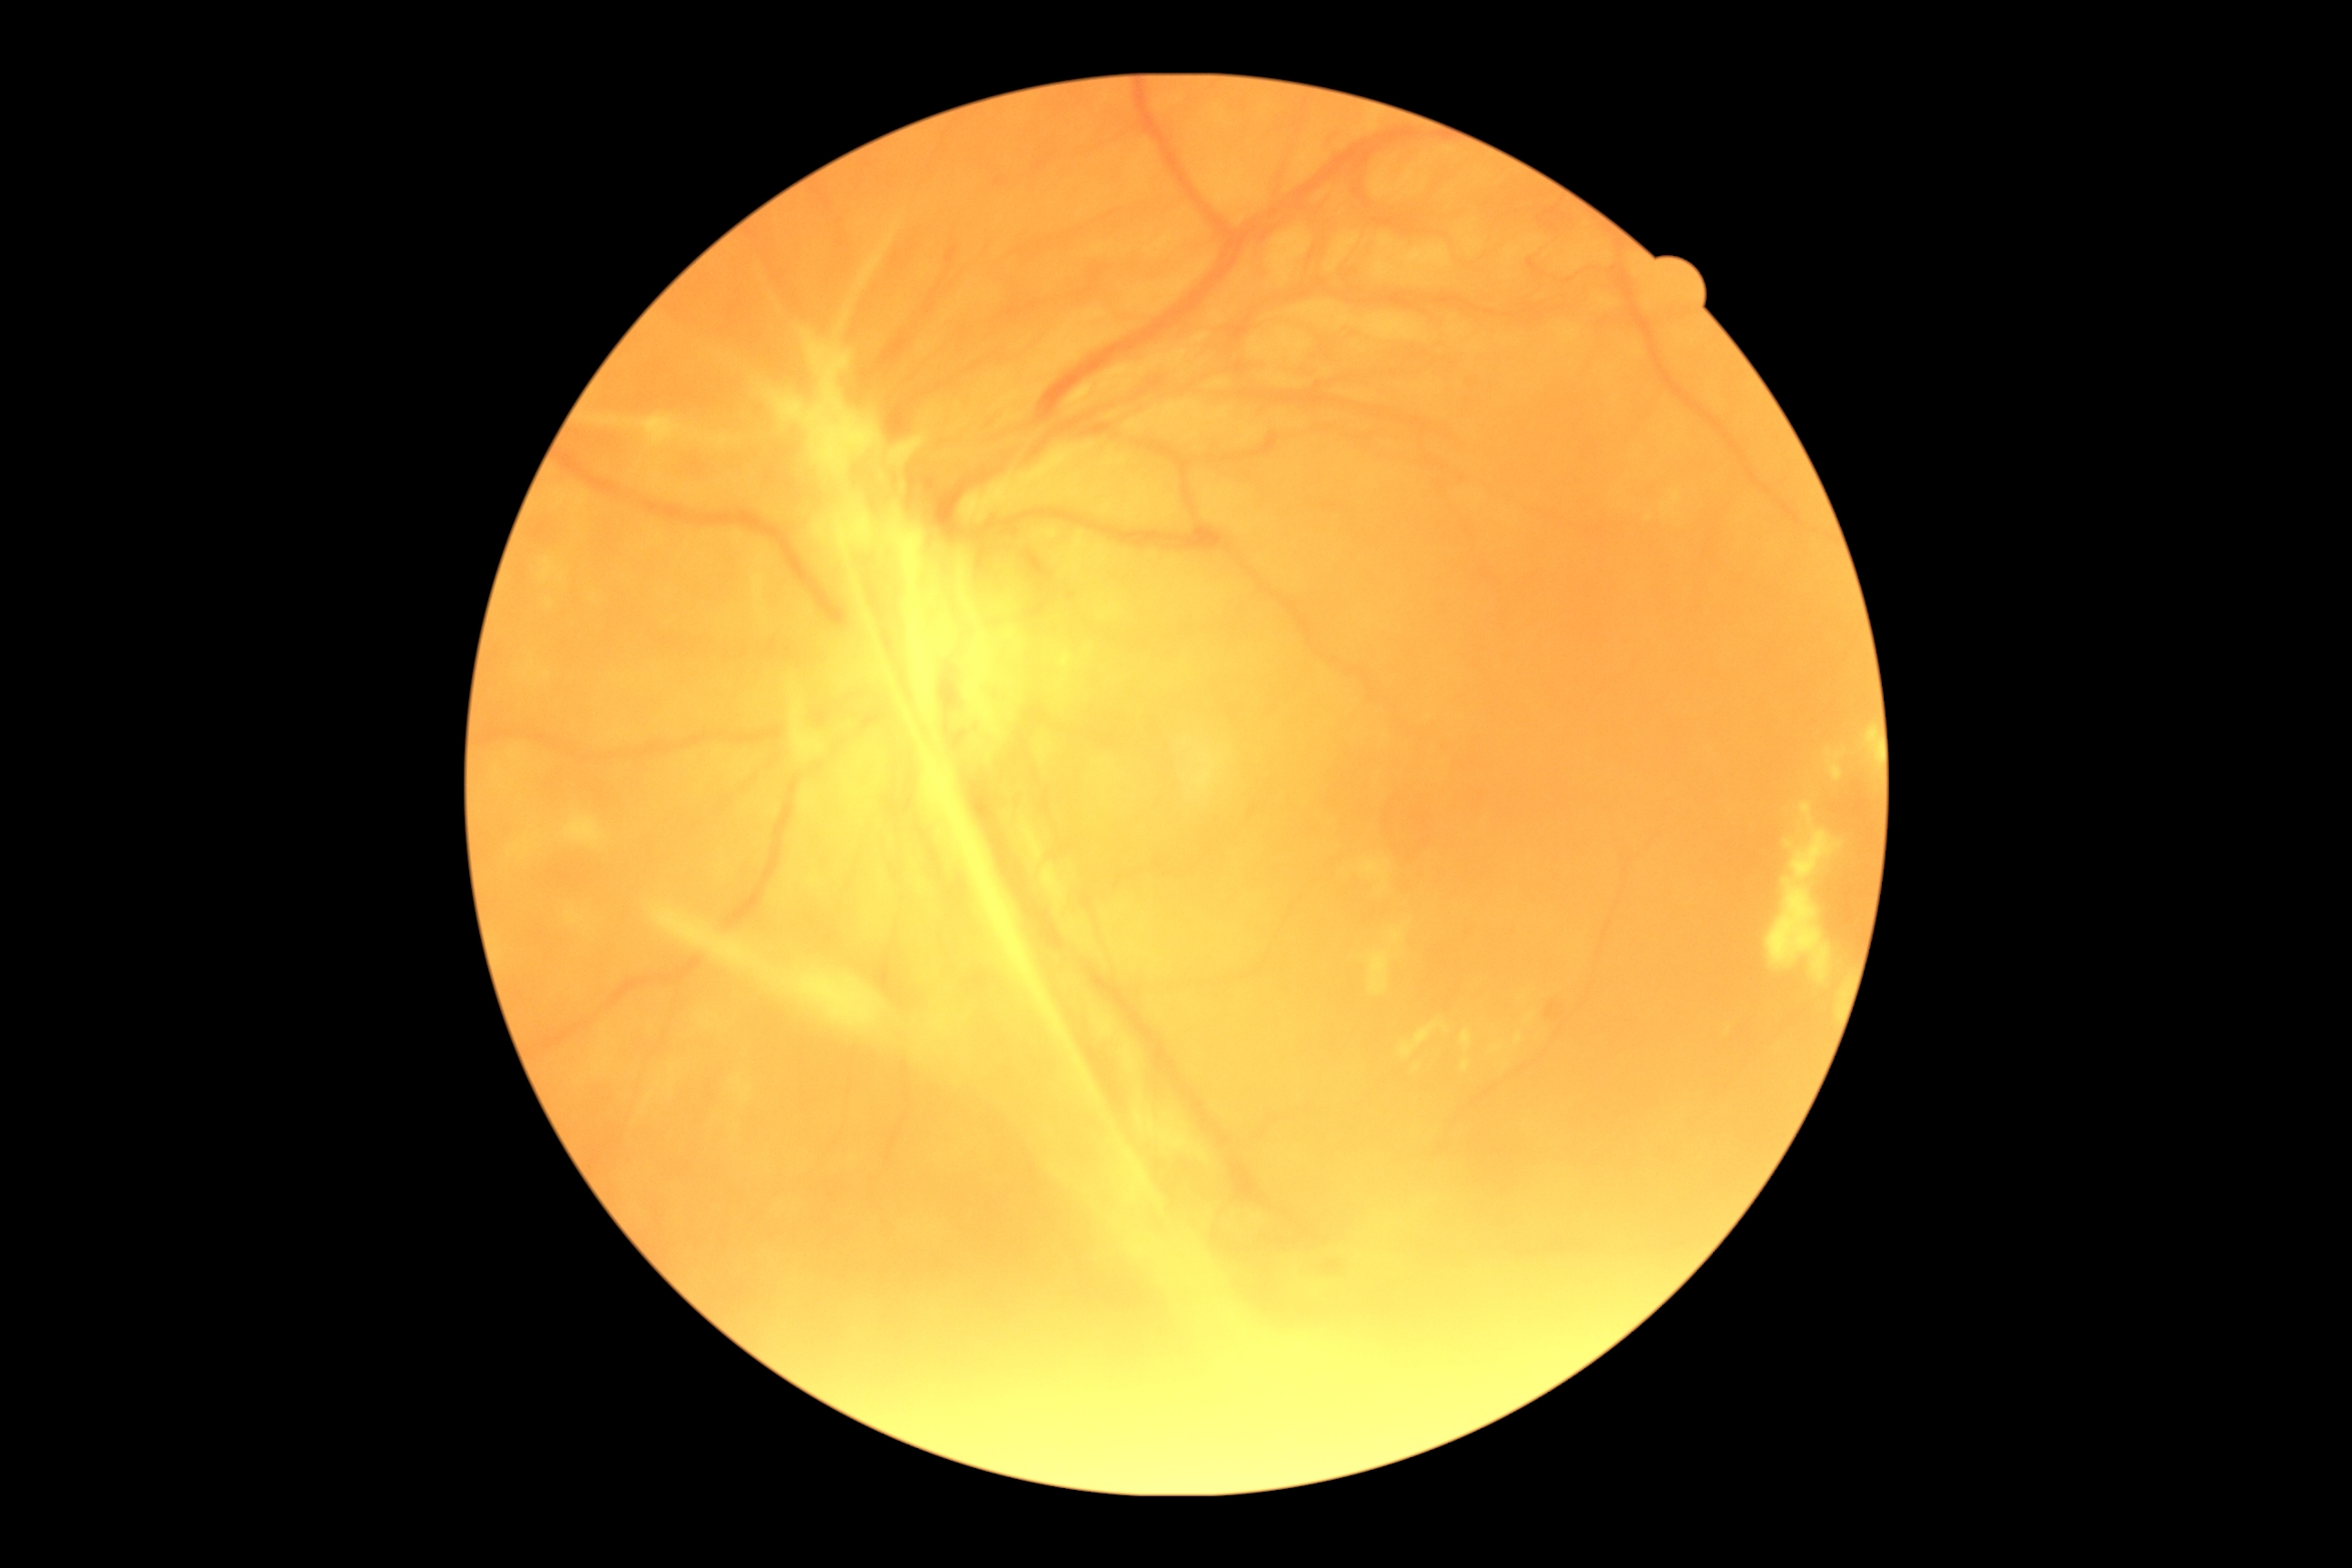

{
  "dr_category": "proliferative diabetic retinopathy",
  "dr_grade": "proliferative diabetic retinopathy (grade 4)"
}